Wide-field fundus photograph from neonatal ROP screening
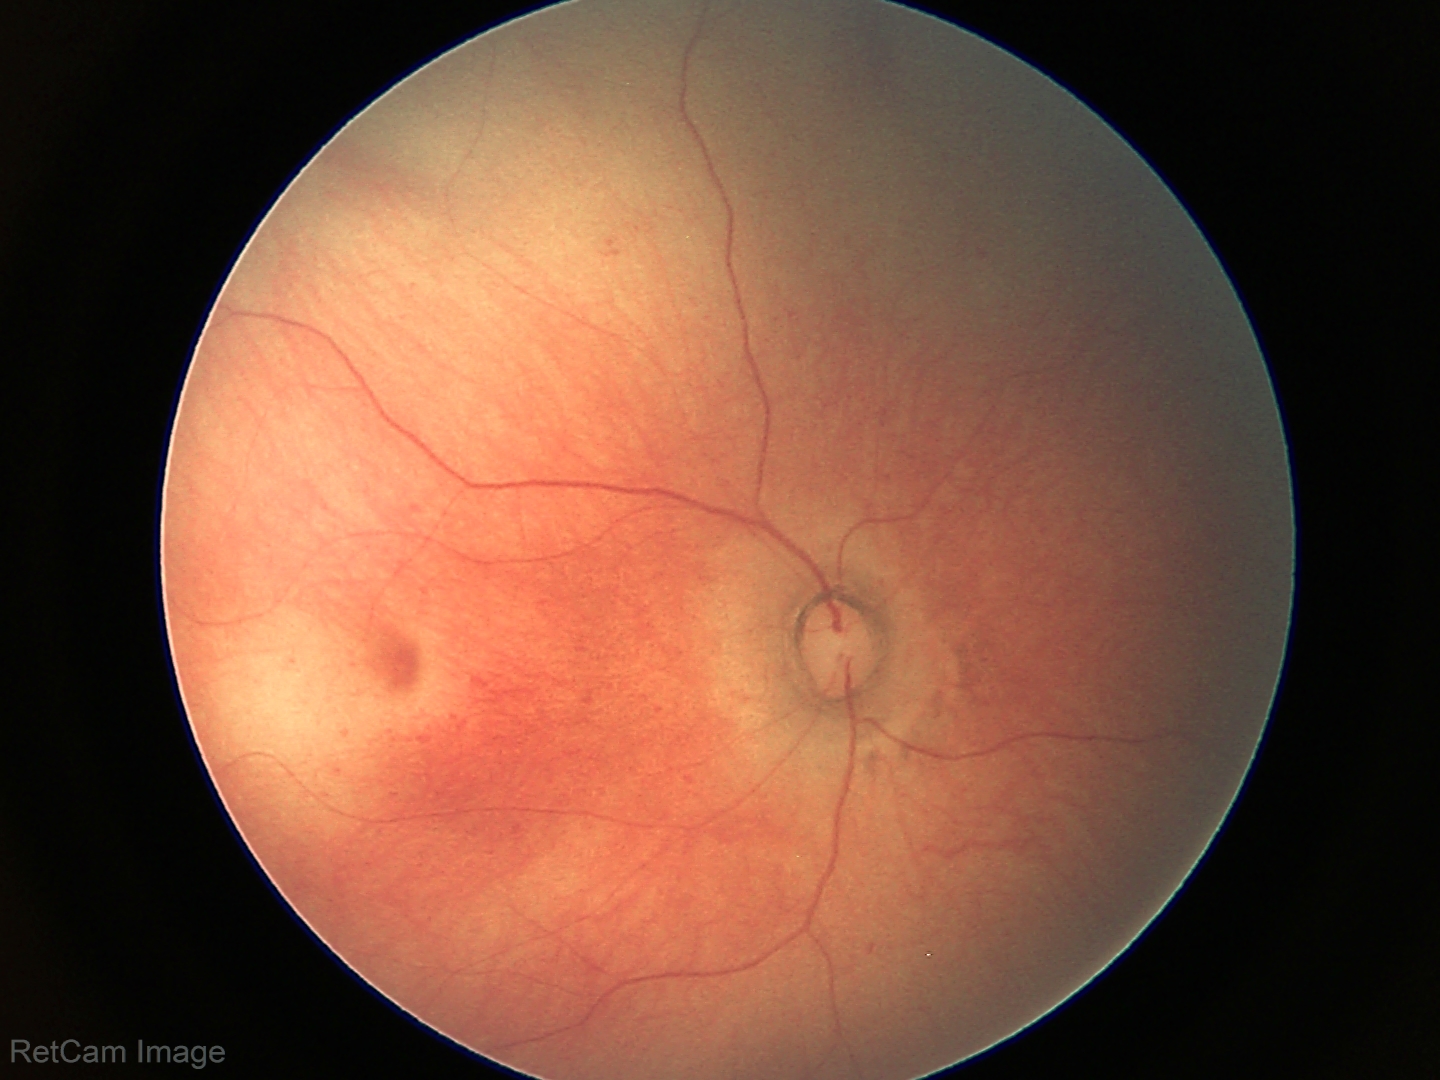 Screening examination diagnosed as physiological.